2048x1536, 45° field of view
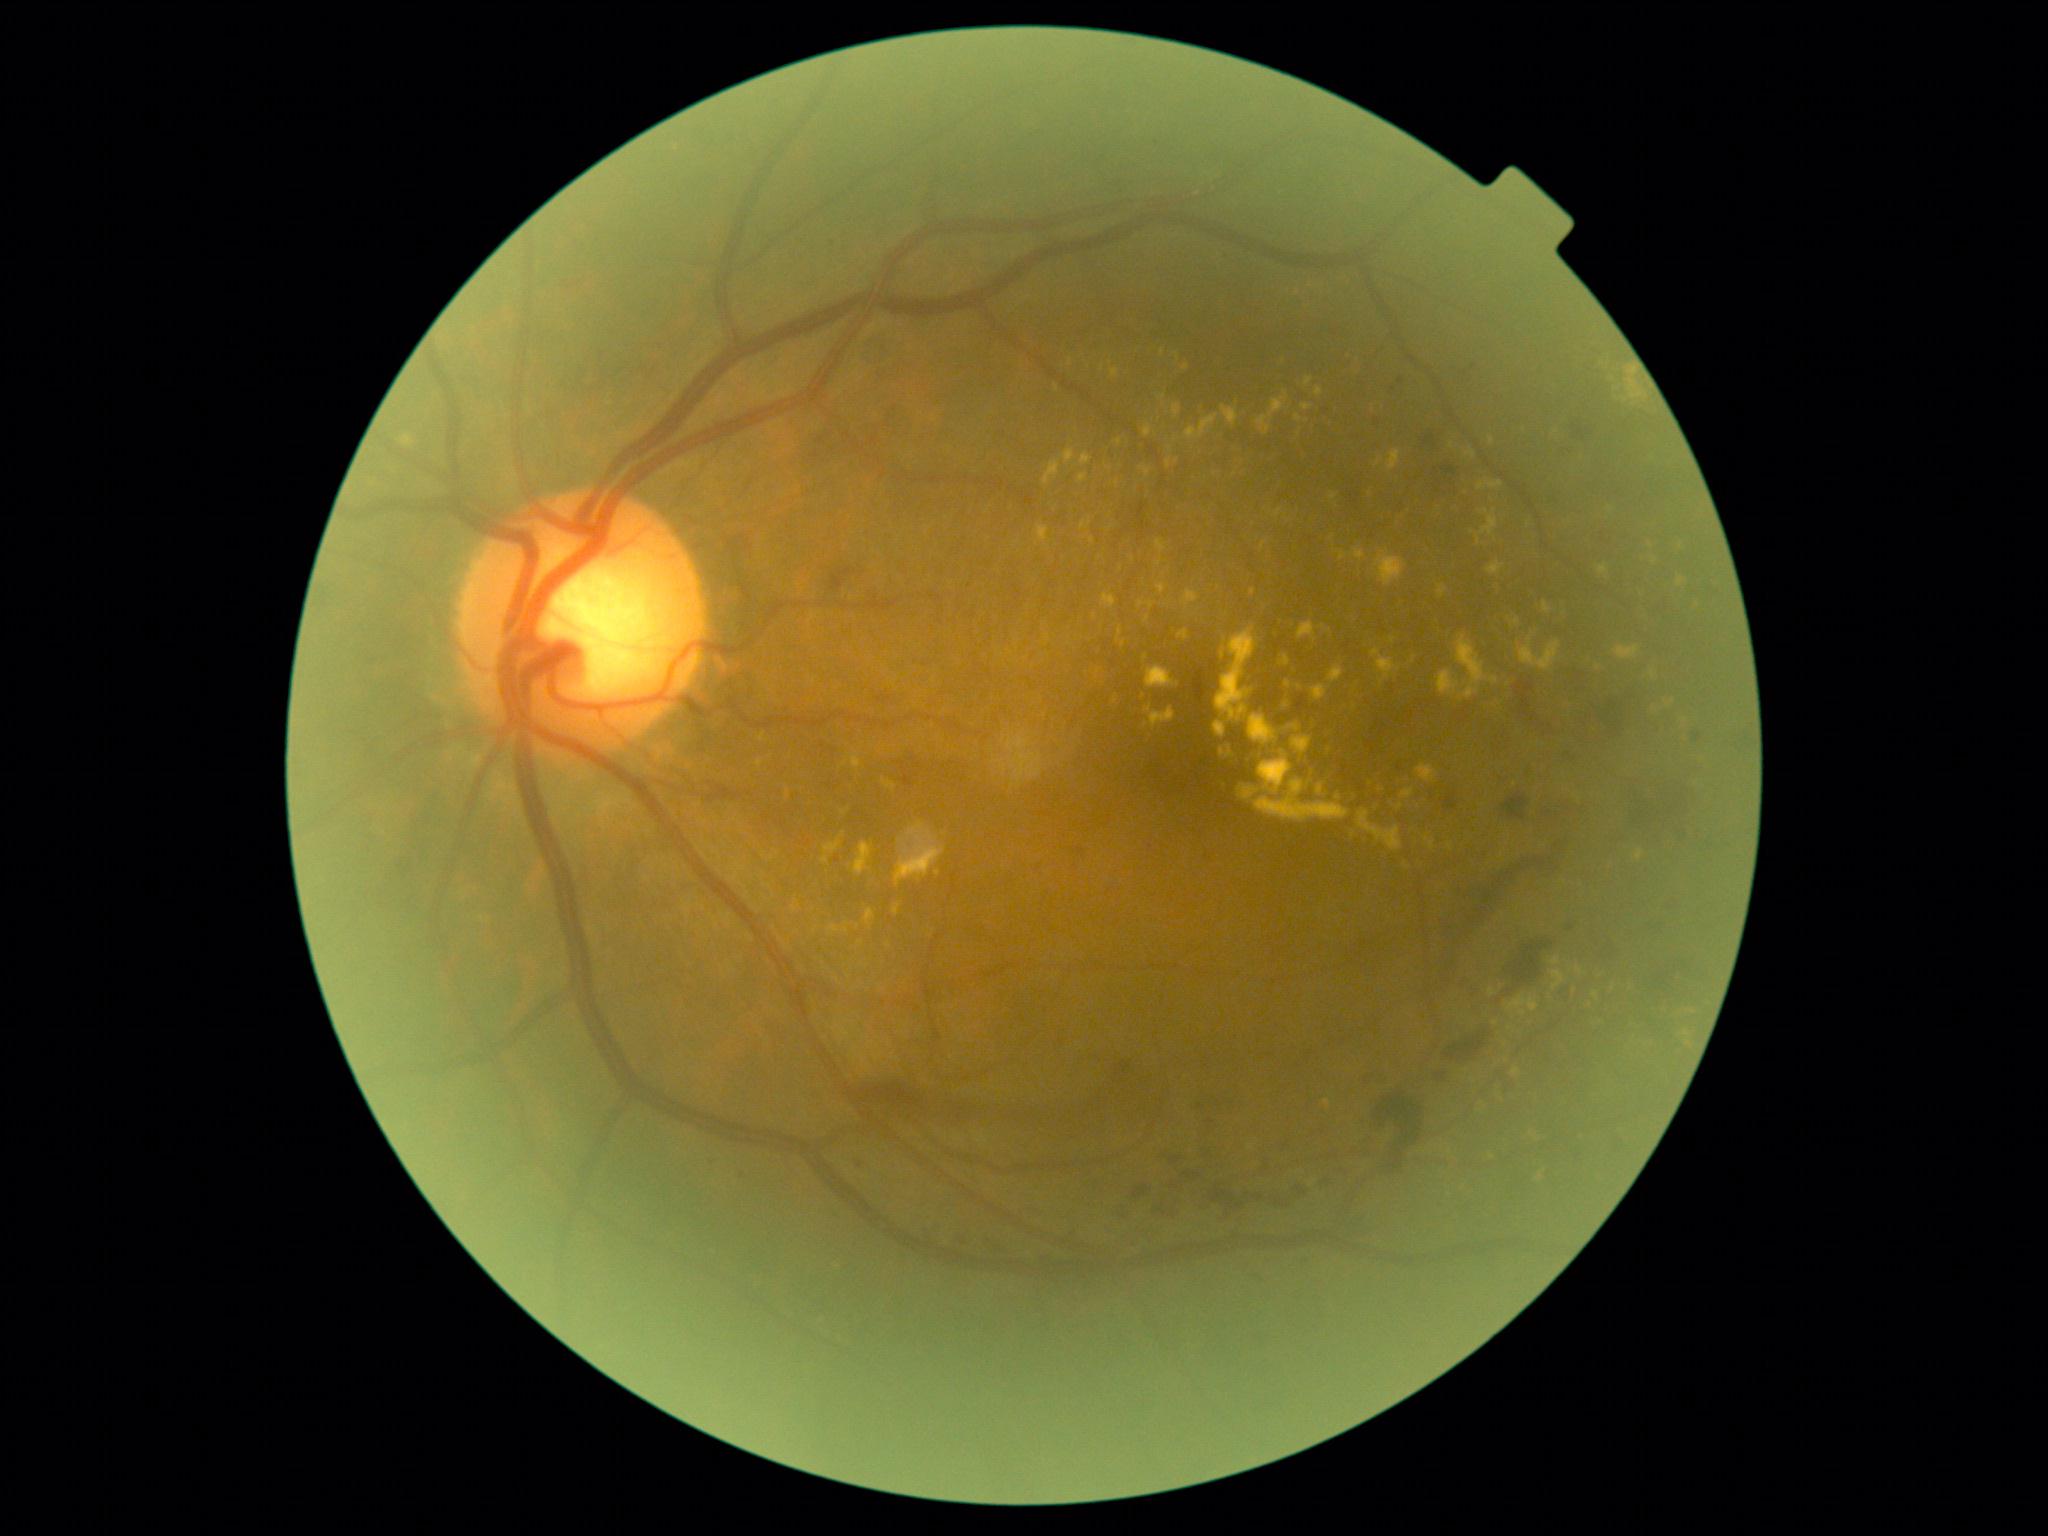

Diabetic retinopathy severity is grade 2 (moderate NPDR)
Selected lesions:
hard exudates (partial): l=1677, t=577, r=1685, b=587 | l=1466, t=450, r=1477, b=460 | l=1375, t=551, r=1406, b=587 | l=1140, t=467, r=1152, b=478 | l=1214, t=722, r=1227, b=738 | l=1328, t=666, r=1344, b=684 | l=1438, t=670, r=1459, b=697 | l=1685, t=1010, r=1695, b=1014 | l=1284, t=681, r=1292, b=689 | l=1513, t=618, r=1520, b=626 | l=1338, t=552, r=1348, b=561 | l=1449, t=442, r=1455, b=450
Small hard exudates near <point>1102, 369</point> | <point>1225, 642</point> | <point>1509, 1029</point> | <point>1330, 632</point> | <point>889, 945</point> | <point>1117, 484</point>